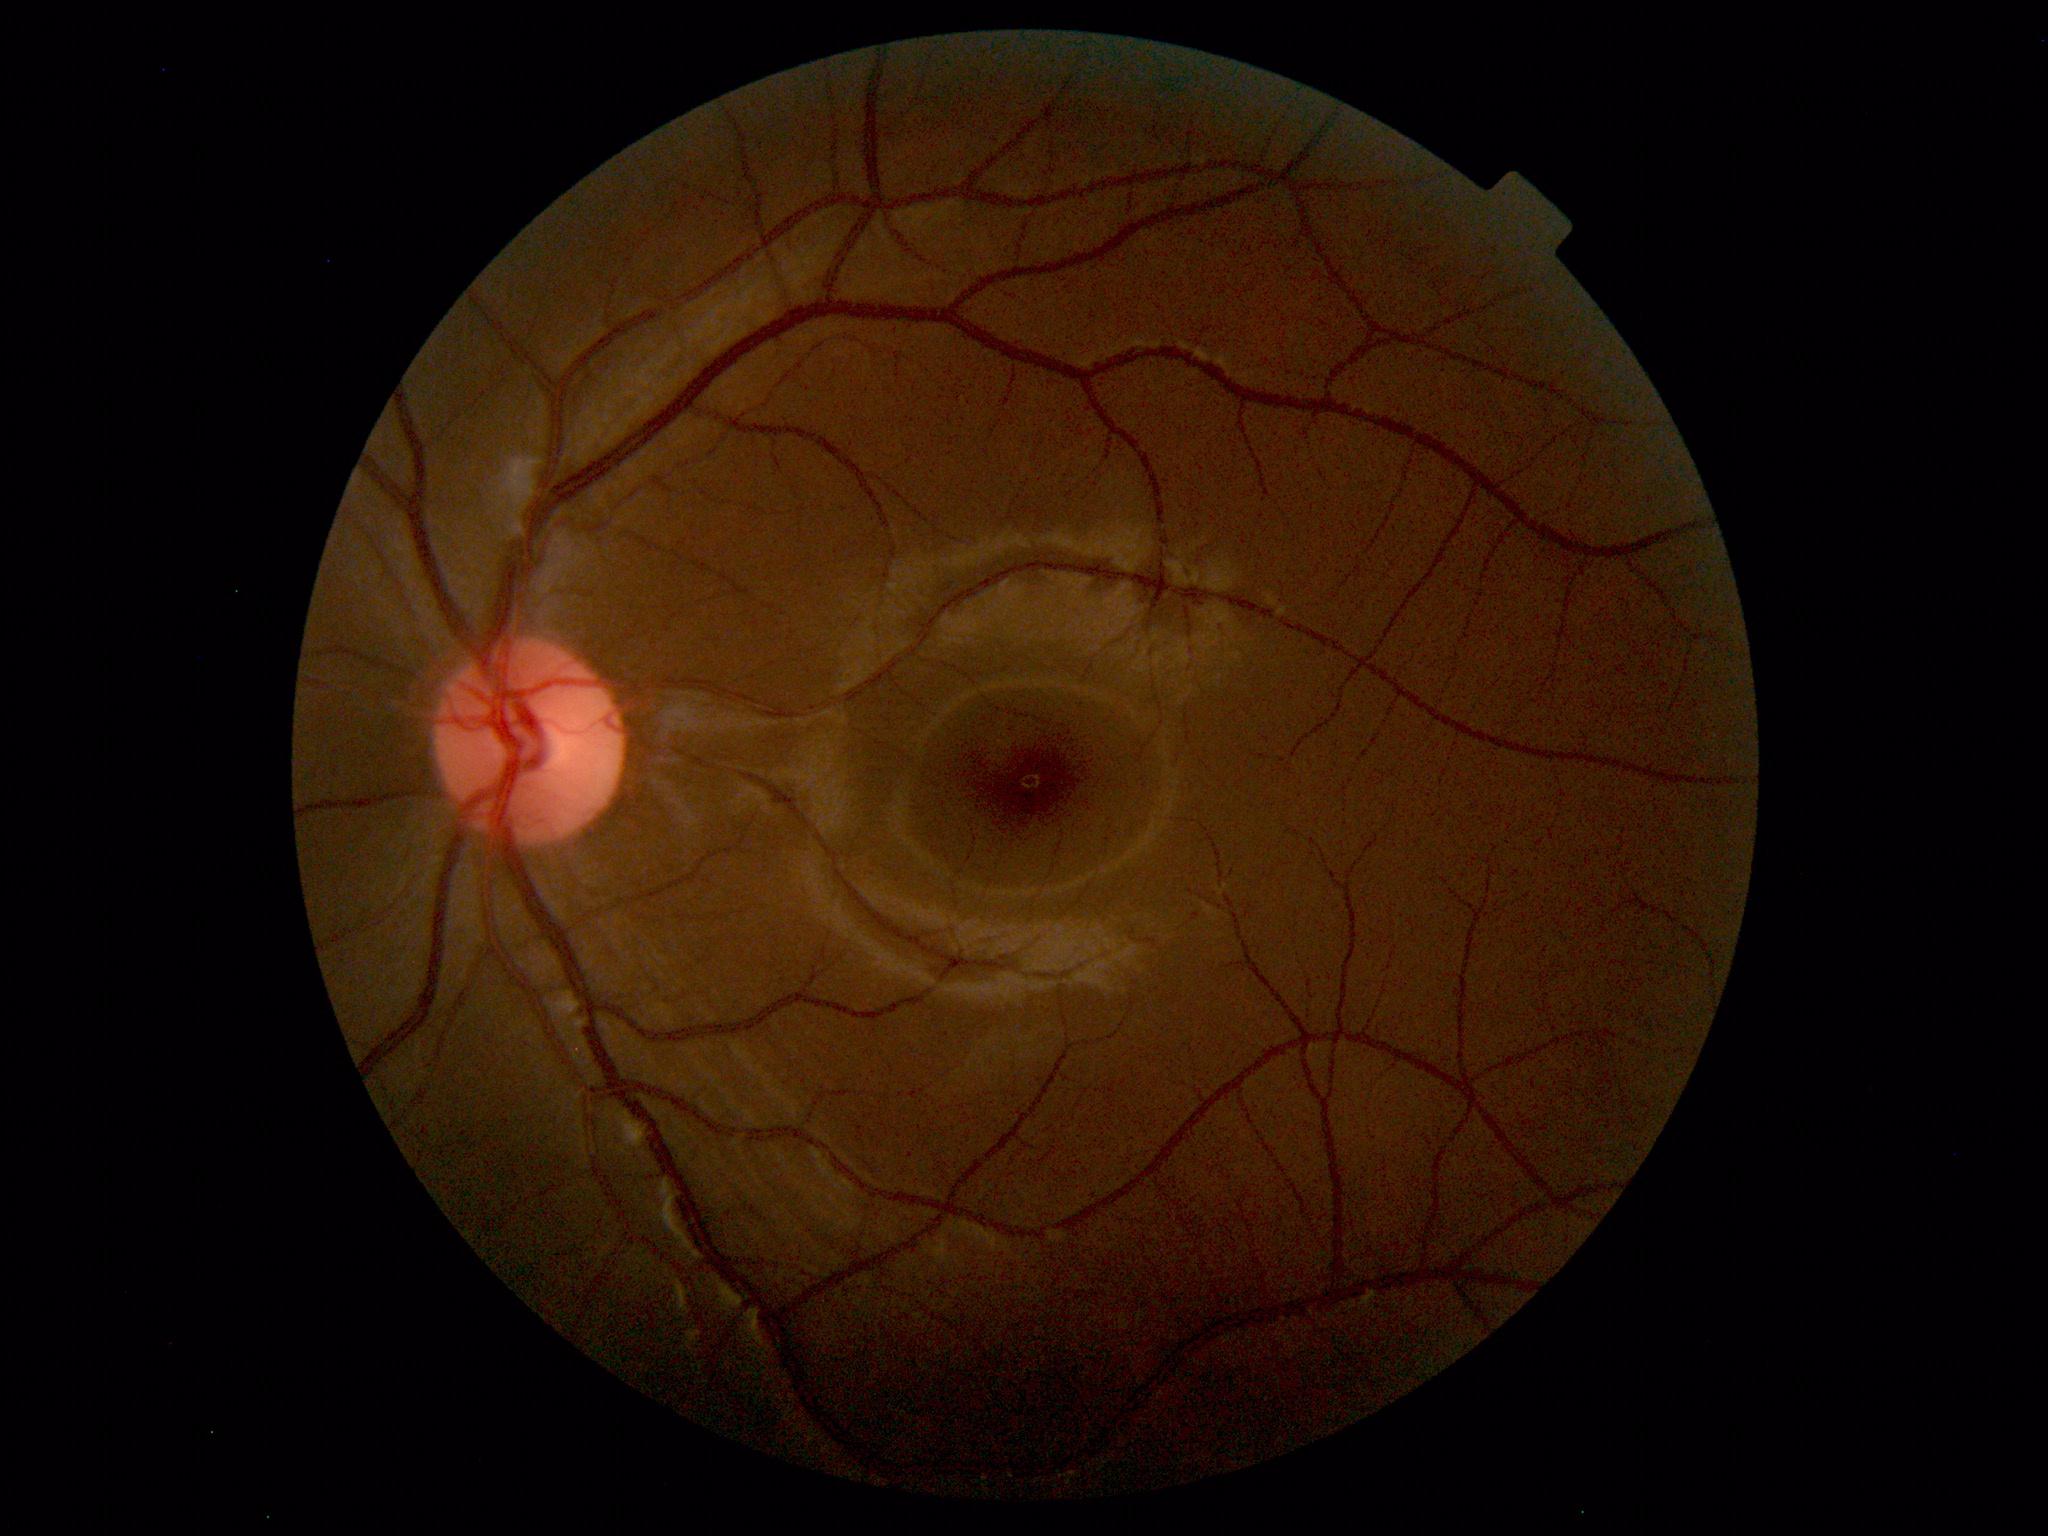 Findings: no abnormalities.